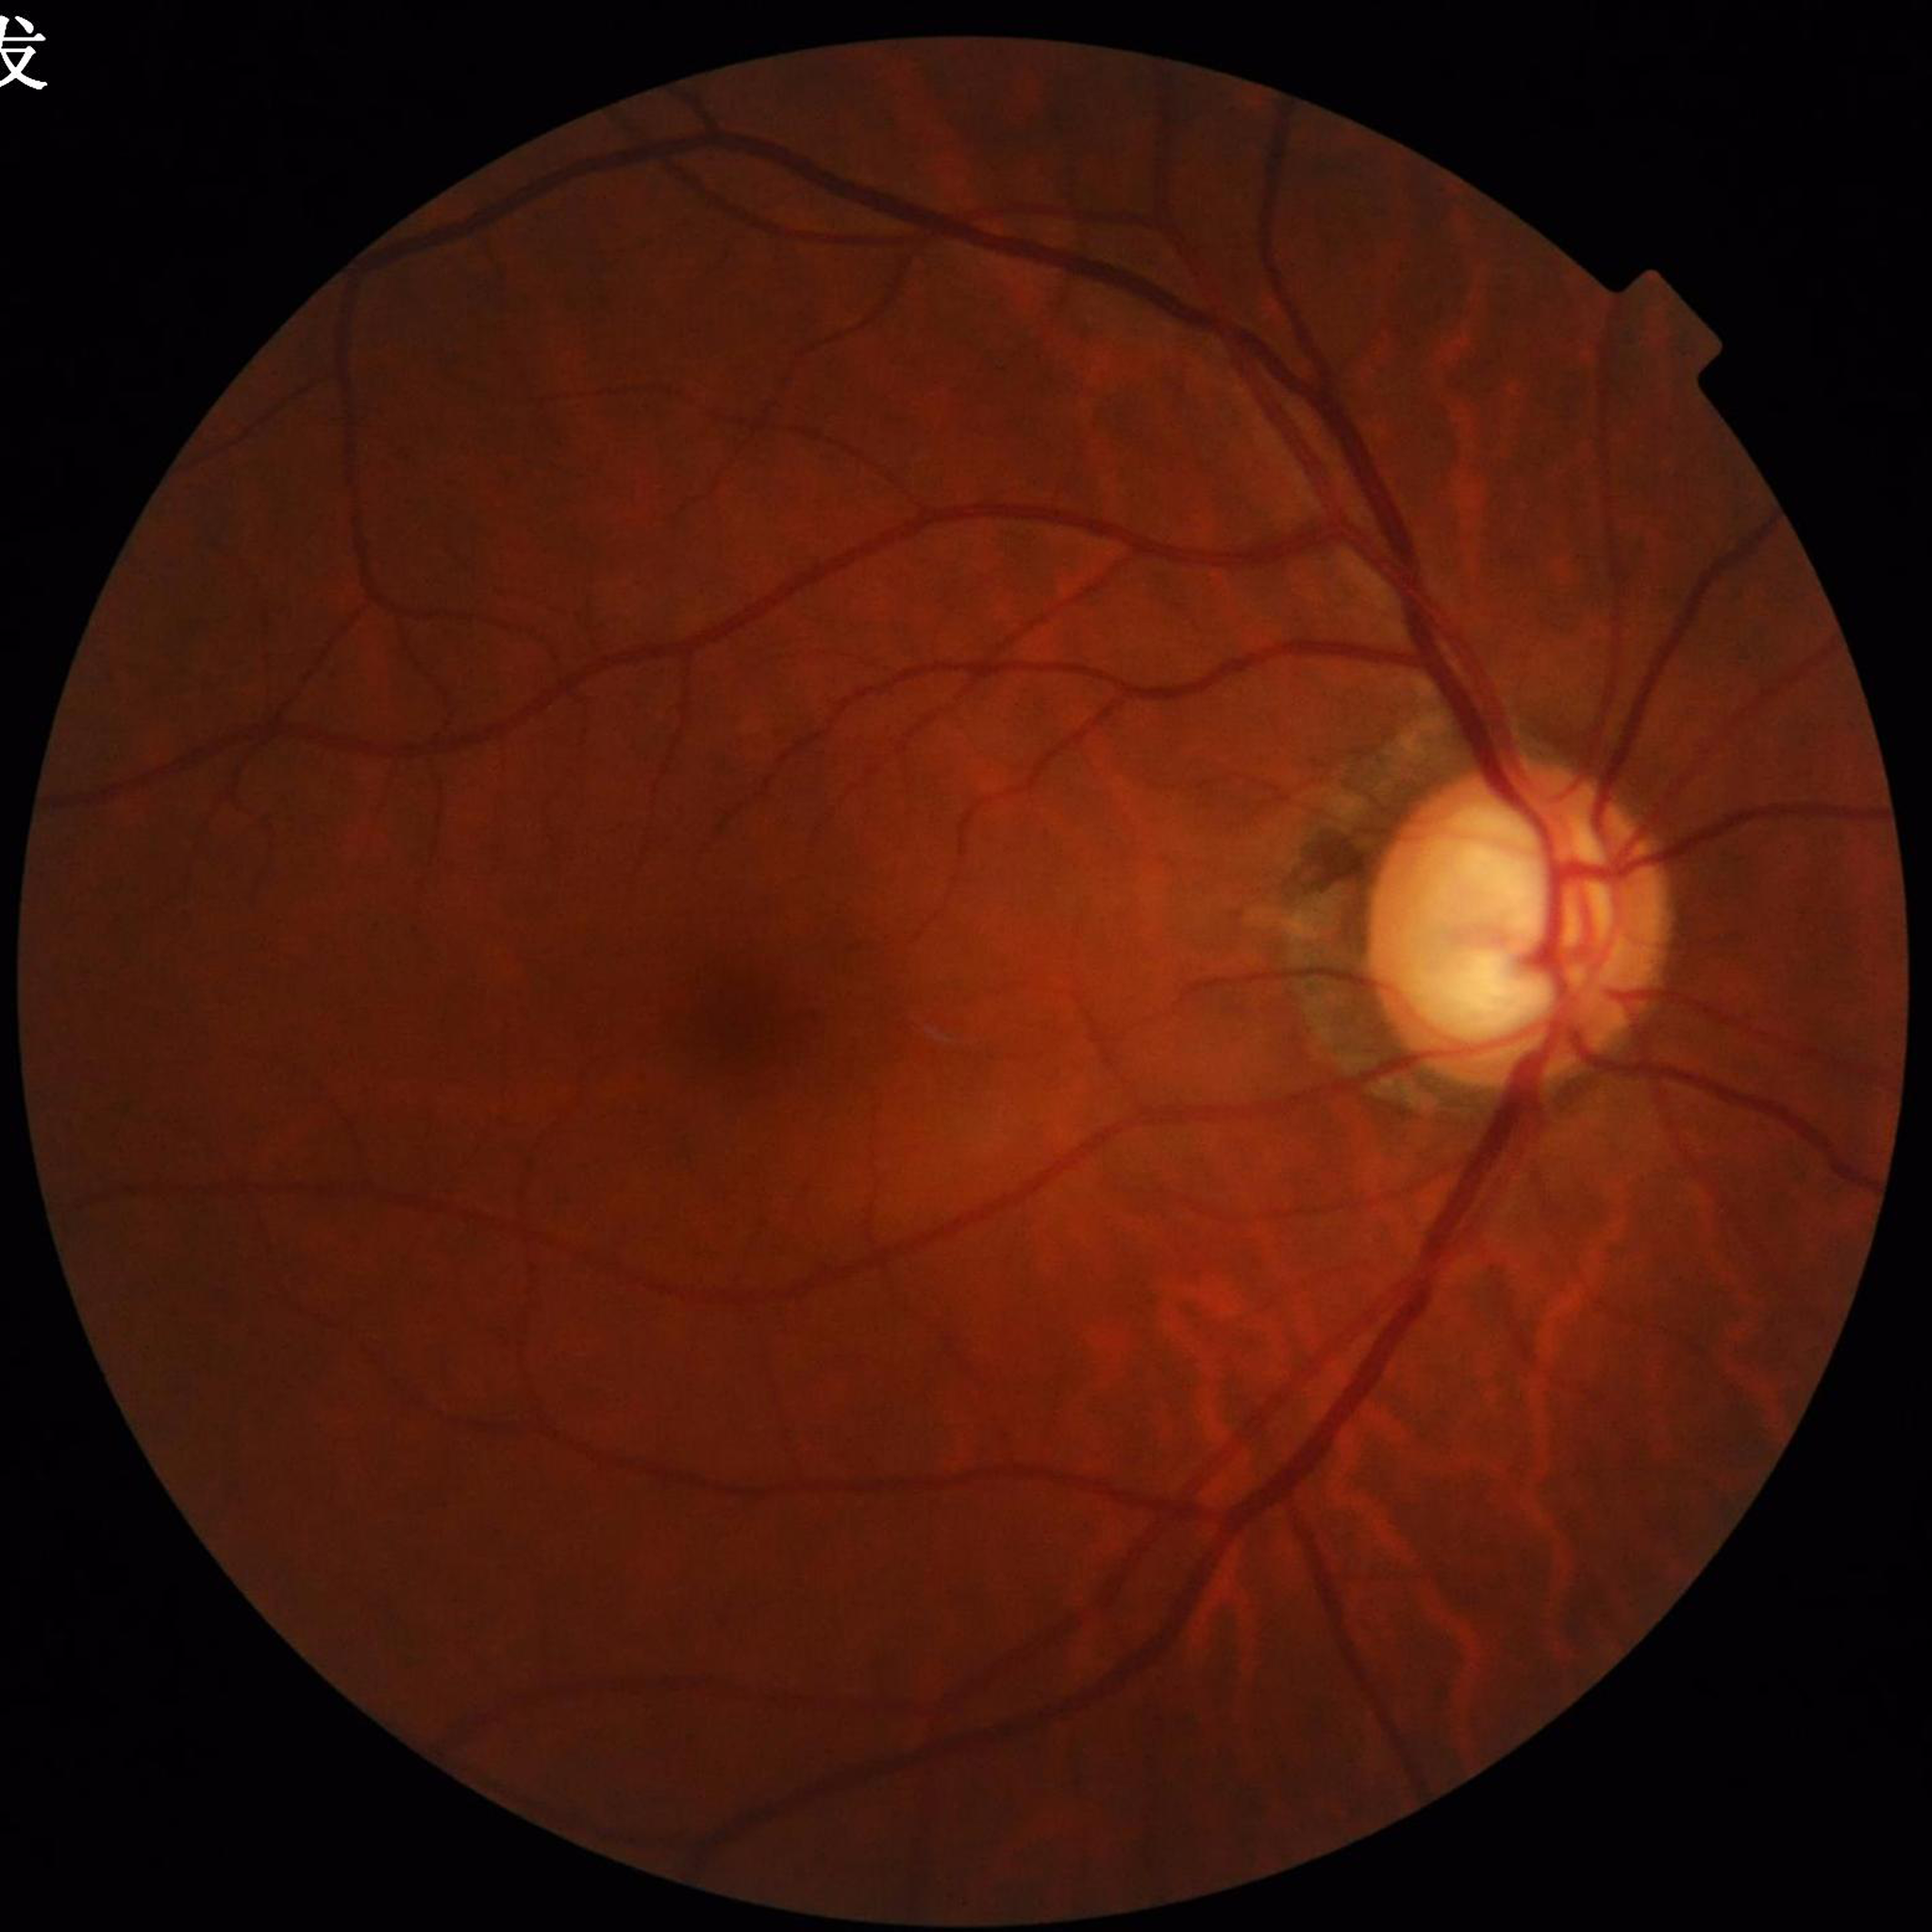
Diagnosis = glaucoma.